Wide-field fundus photograph from neonatal ROP screening; acquired on the Clarity RetCam 3: 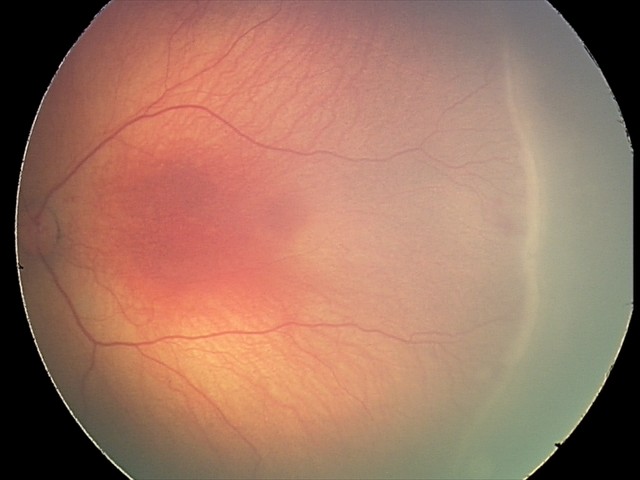
Without plus disease. Screening series with ROP stage 2 — ridge with height and width at the demarcation line.